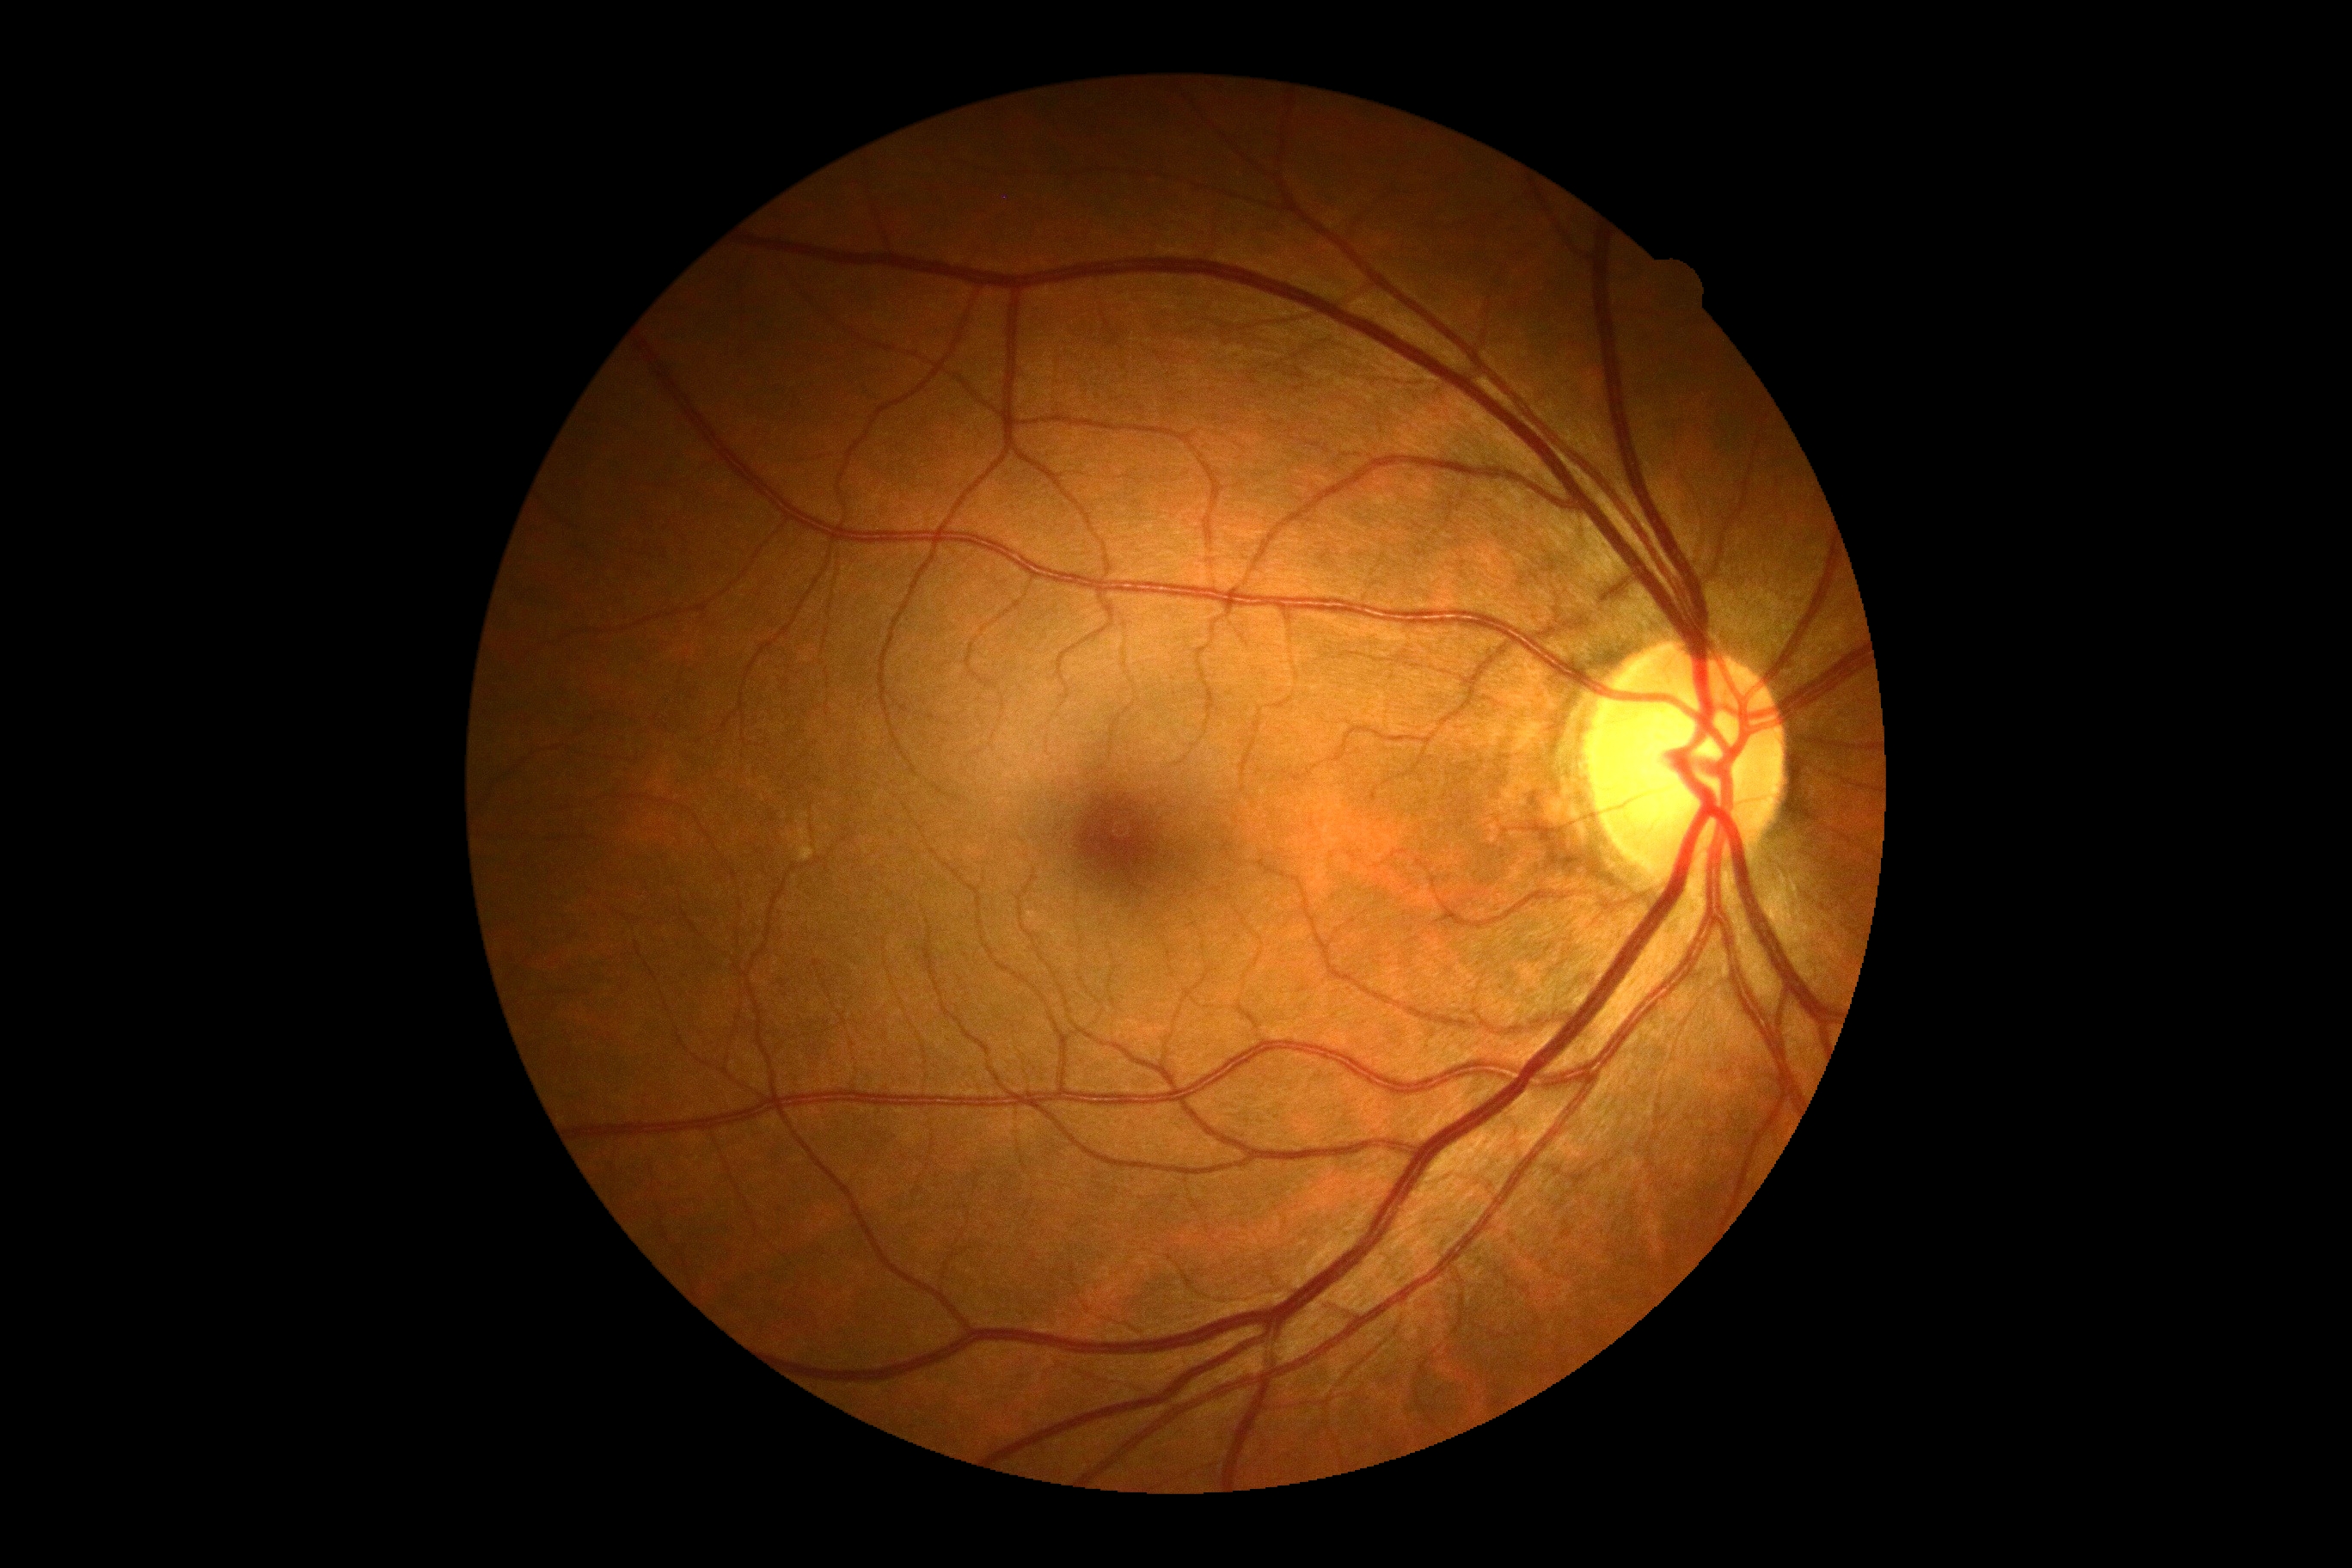
No signs of diabetic retinopathy. DR: grade 0 (no apparent retinopathy).